Wide-field contact fundus photograph of an infant; 1240x1240.
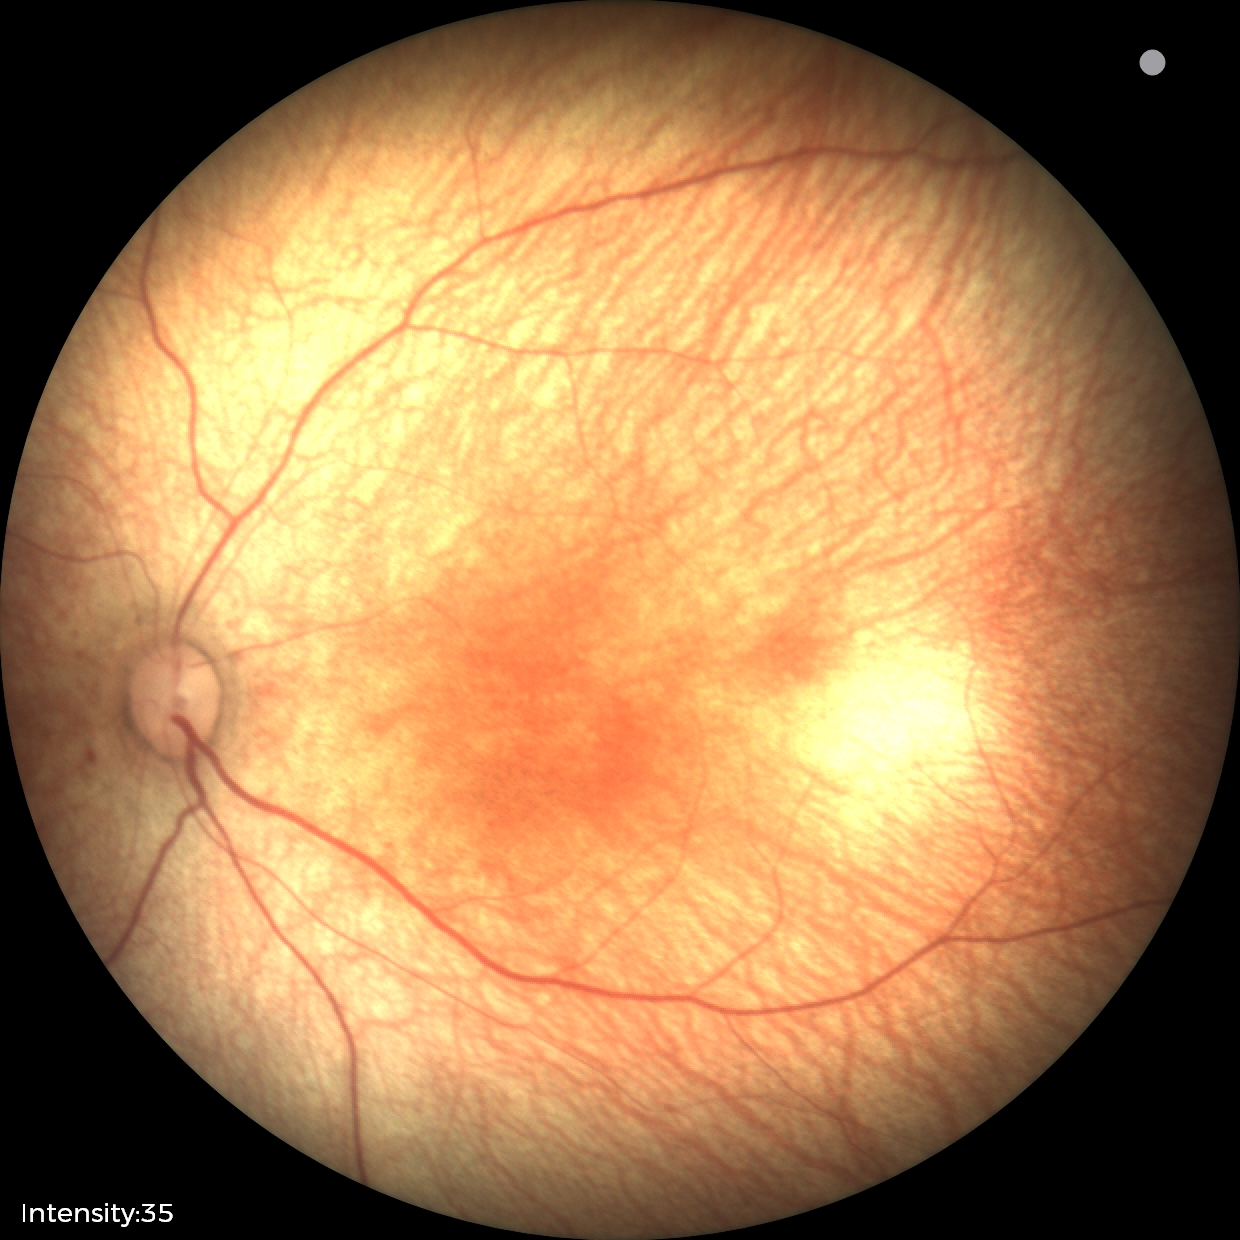

Screening diagnosis = no pathology identified